Color fundus photograph — 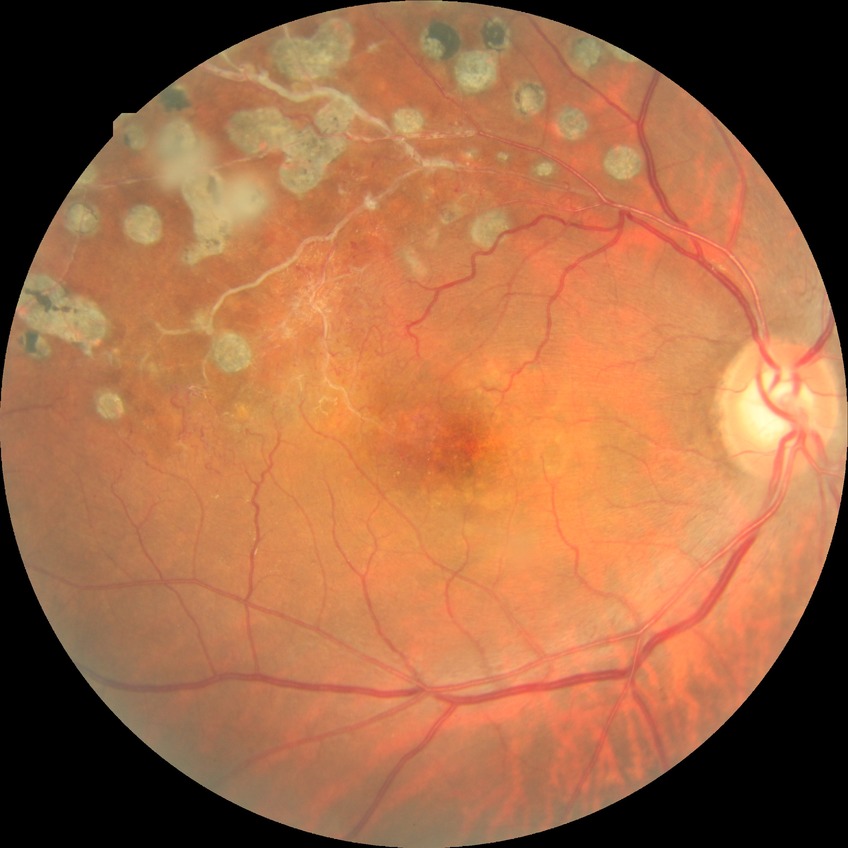

{"davis_grade": "PDR"}